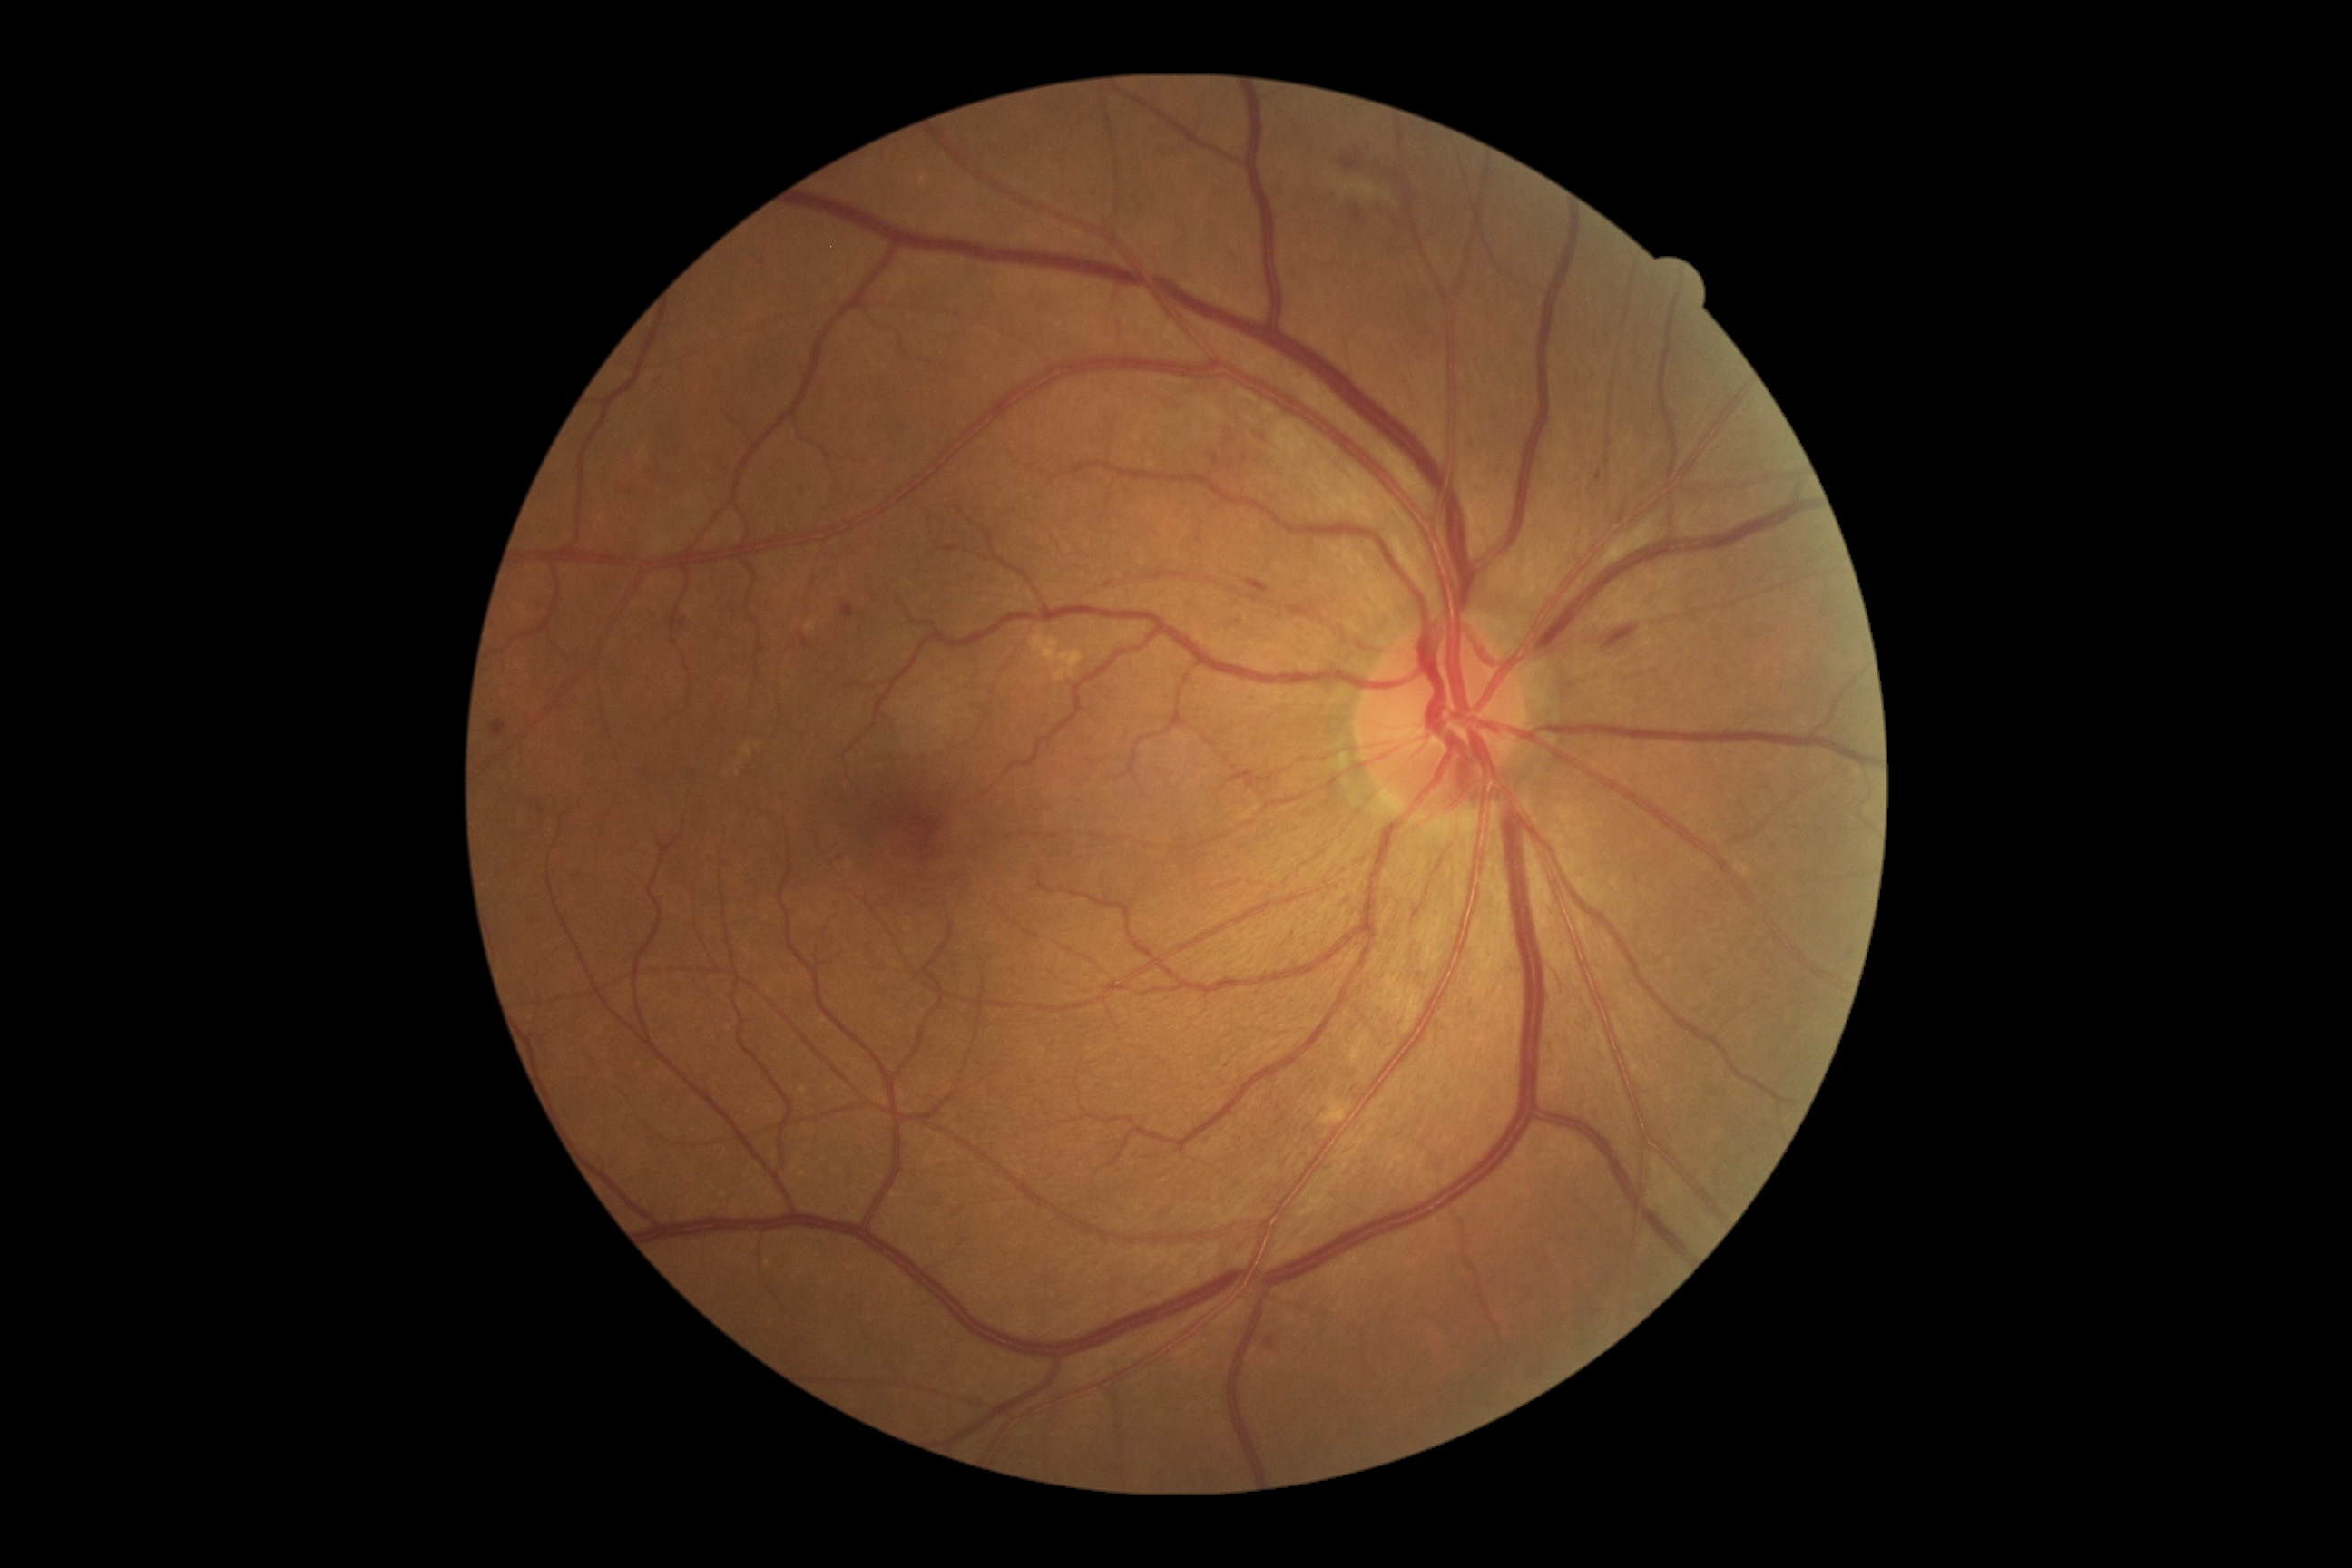

The retinopathy is classified as non-proliferative diabetic retinopathy. DR: 2 — more than just microaneurysms but less than severe NPDR.